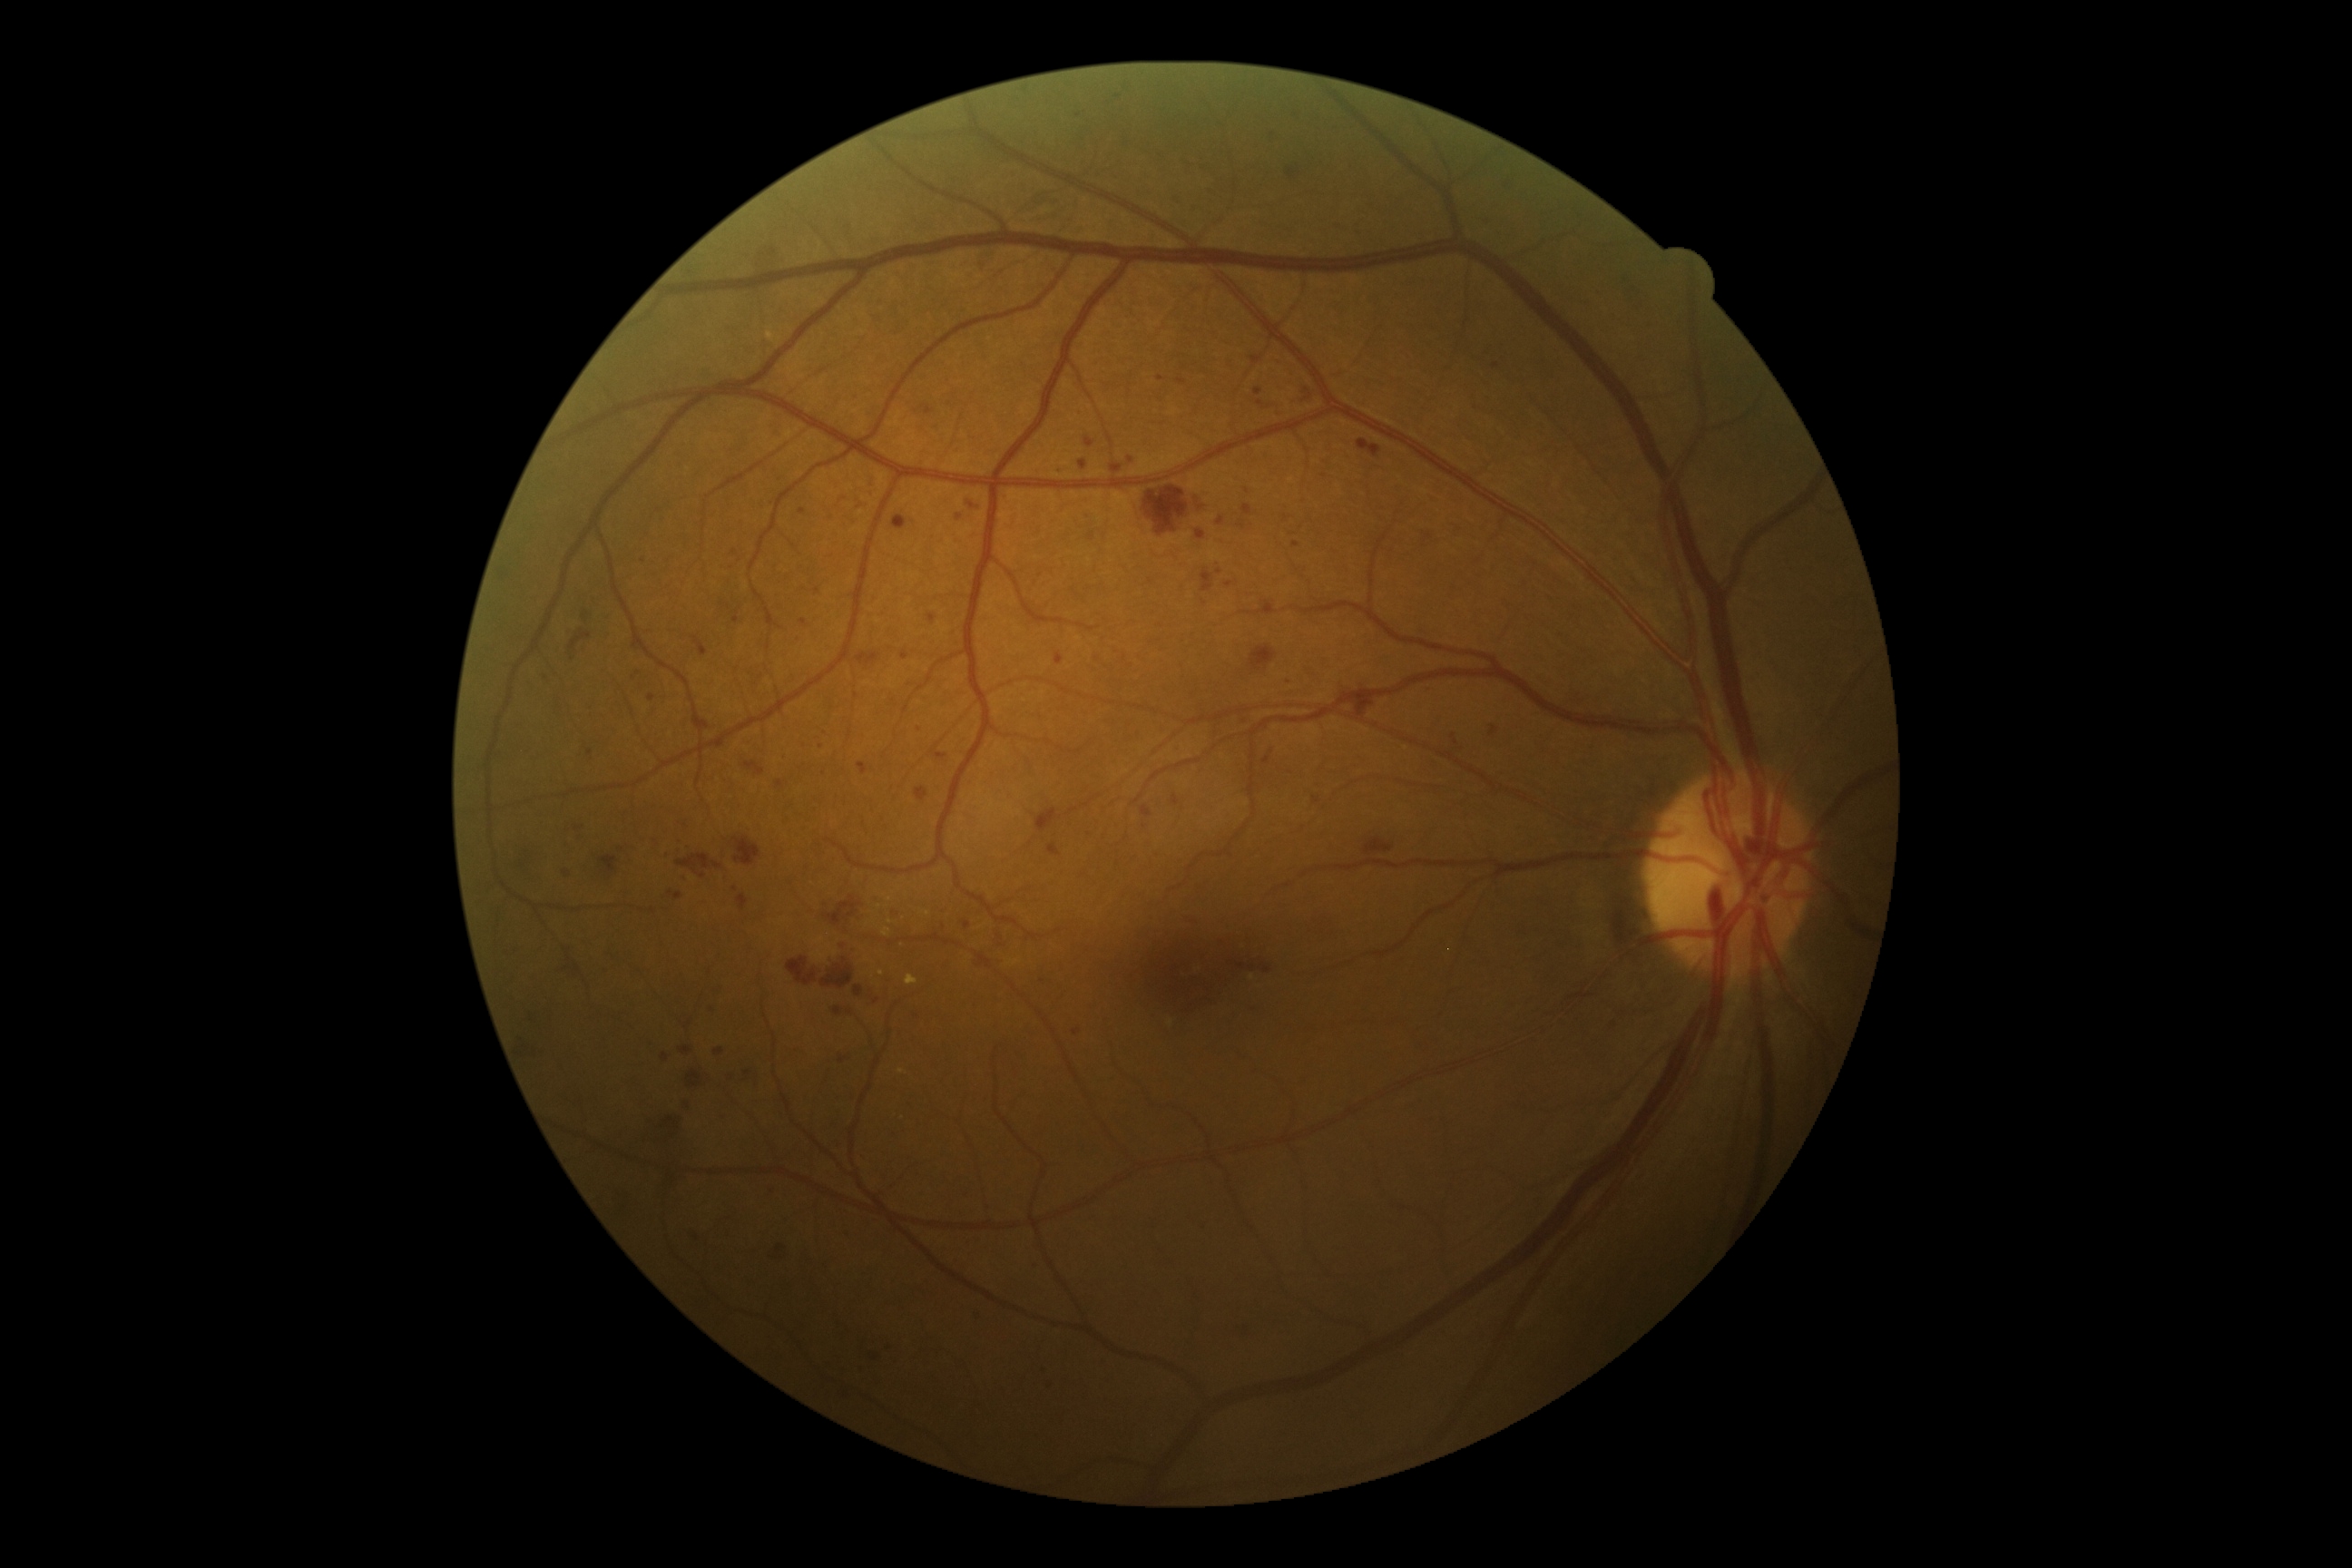
DR stage: severe non-proliferative diabetic retinopathy (grade 3).